Wide-field fundus photograph from neonatal ROP screening: 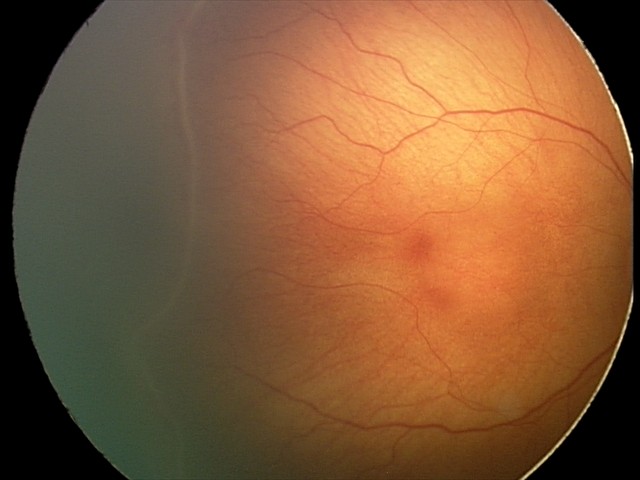

No plus disease.
From an examination with diagnosis of retinopathy of prematurity stage 2.